Color fundus photograph:
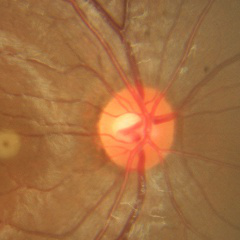 Glaucoma assessment = no glaucoma.